848 by 848 pixels, posterior pole photograph, modified Davis classification:
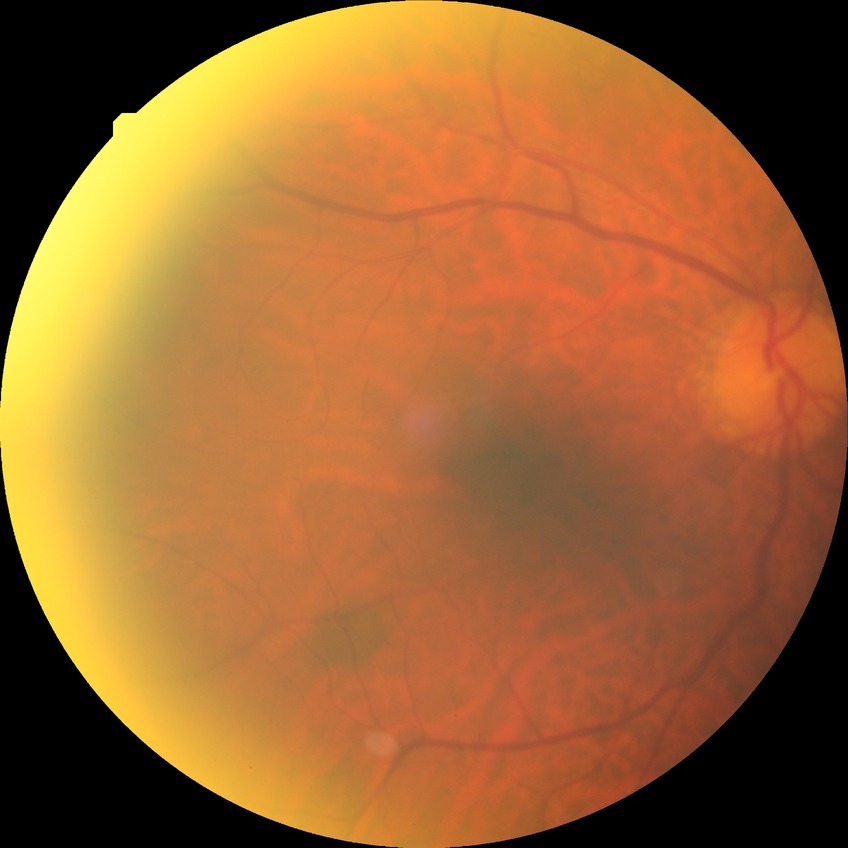

Annotations:
– modified Davis classification: no diabetic retinopathy